Nonmydriatic; DR severity per modified Davis staging; FOV: 45 degrees
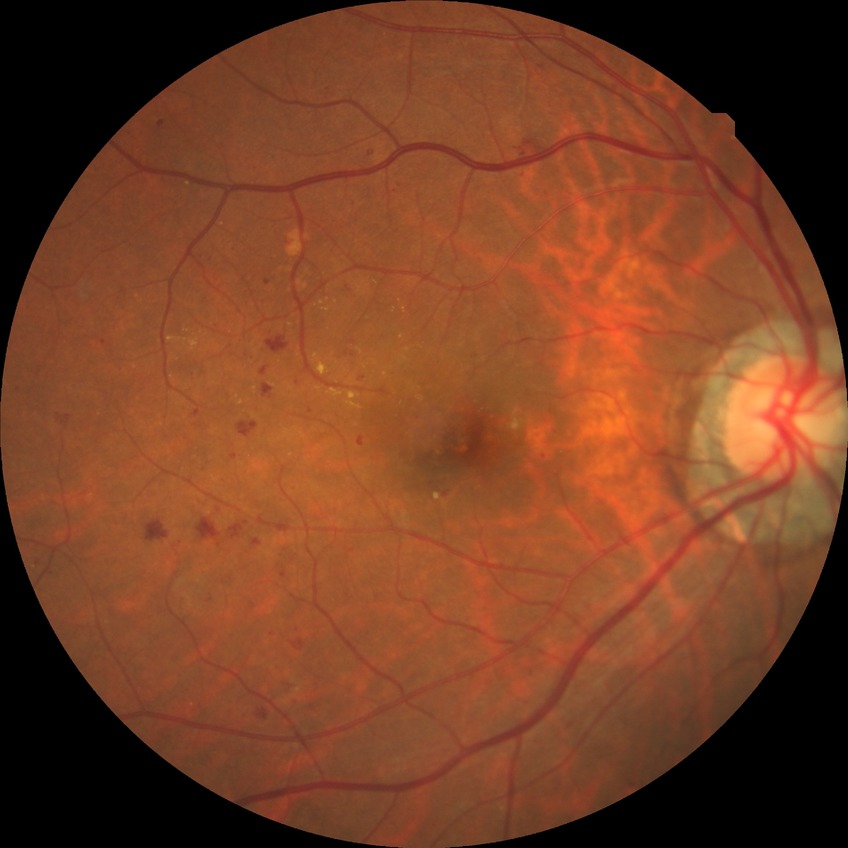
Diabetic retinopathy (DR) is SDR (simple diabetic retinopathy). DR class: non-proliferative diabetic retinopathy.